NIDEK AFC-230 fundus camera, modified Davis grading.
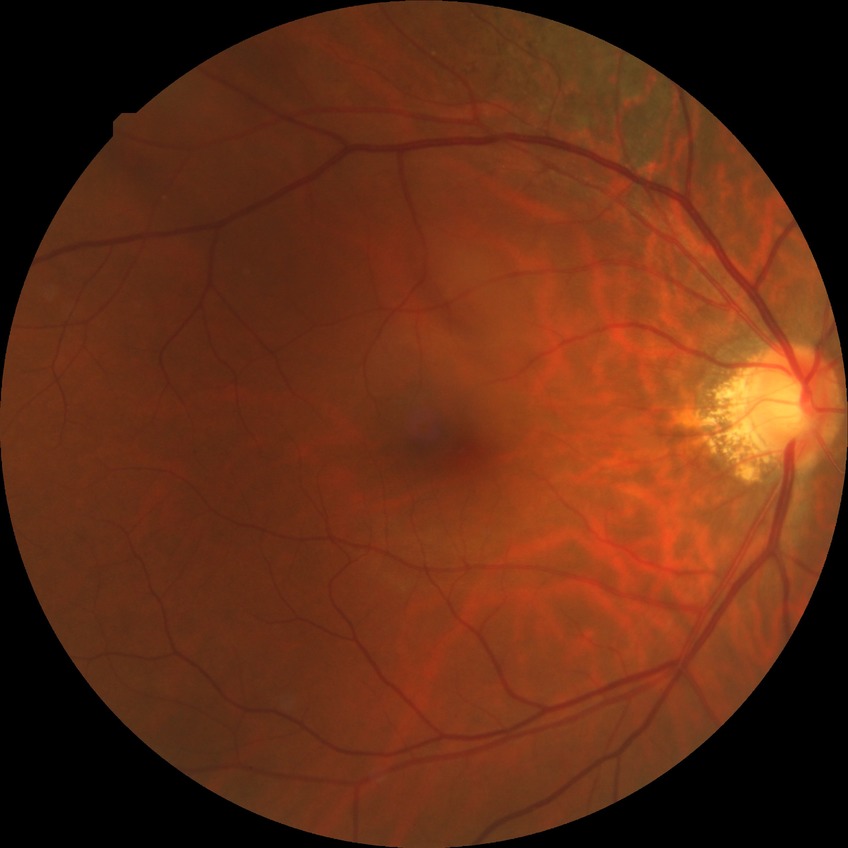

No DR findings.
Davis grade: NDR.